2212 x 1659 pixels, color fundus photograph — 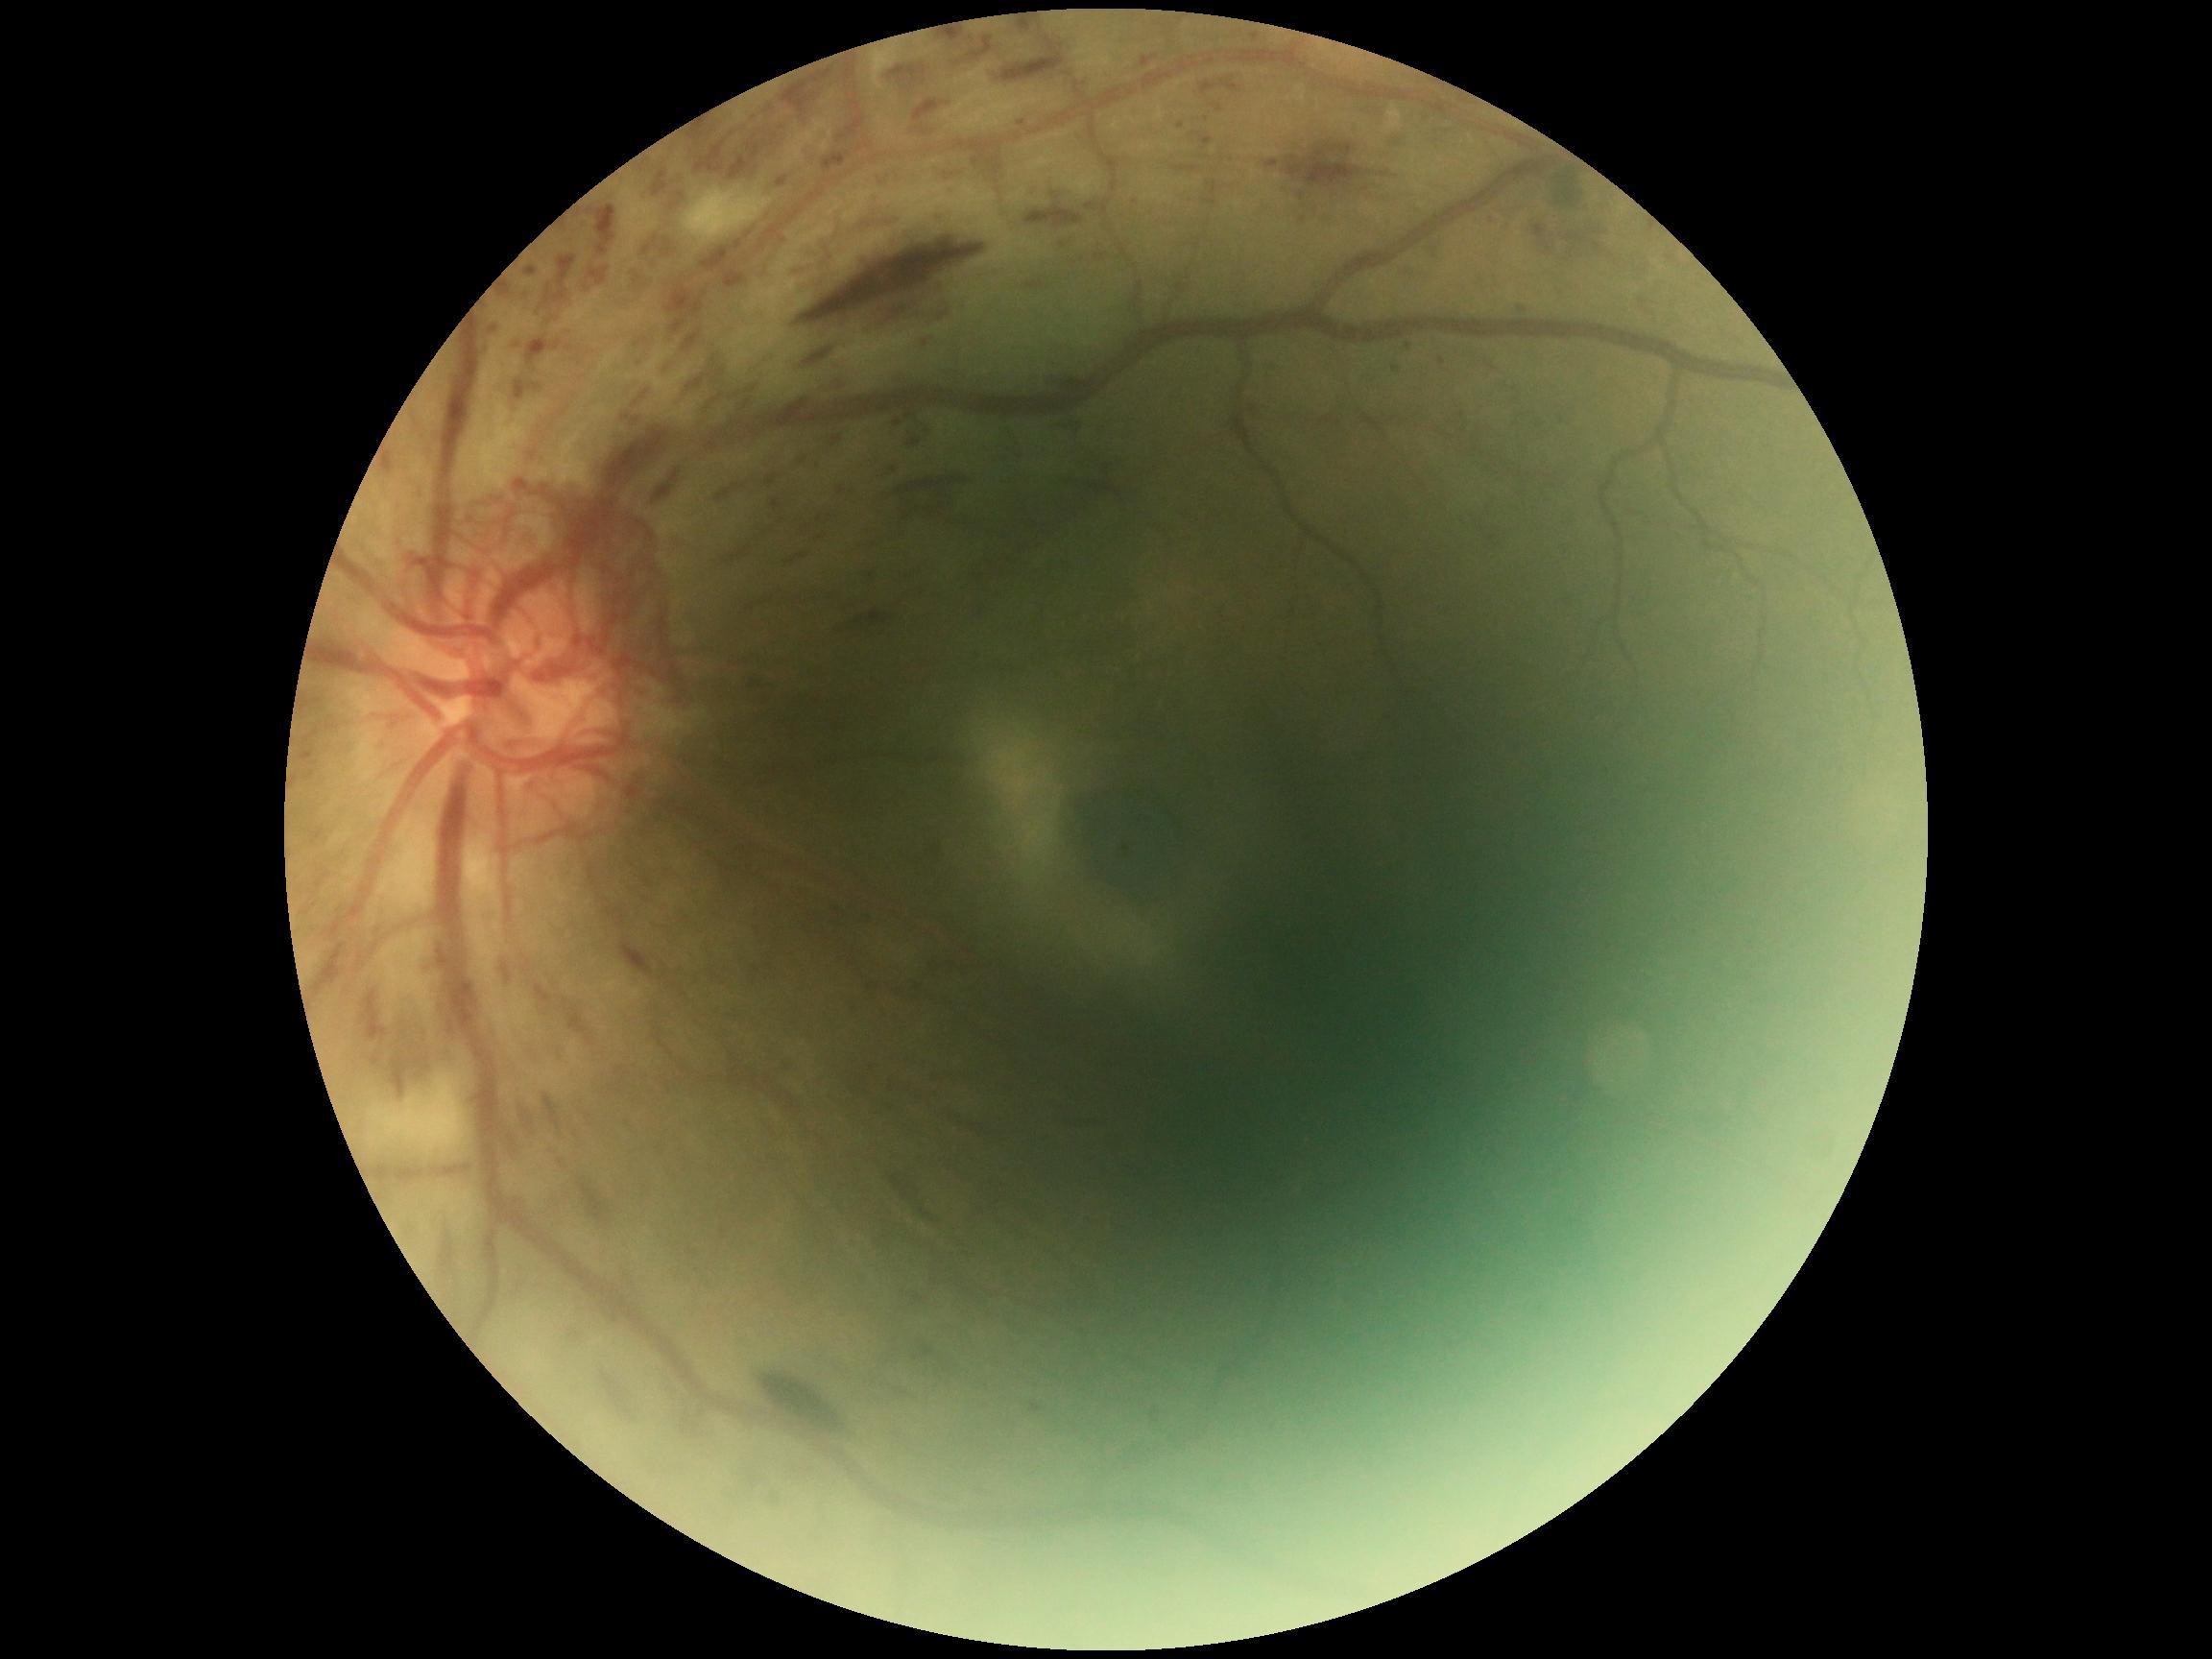

DR stage is grade 4 (PDR).